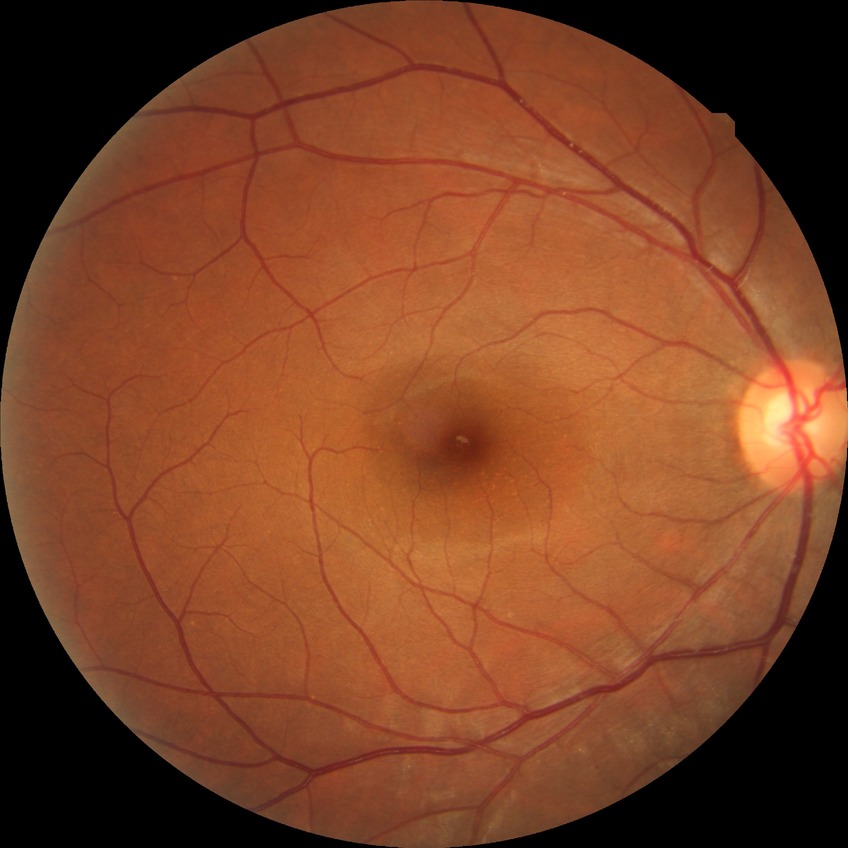

Diabetic retinopathy severity: no diabetic retinopathy.